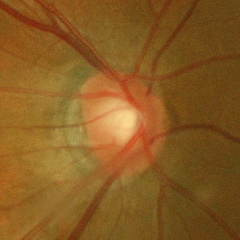 Q: Glaucoma assessment?
A: Early glaucomatous changes.